Retinal fundus photograph: 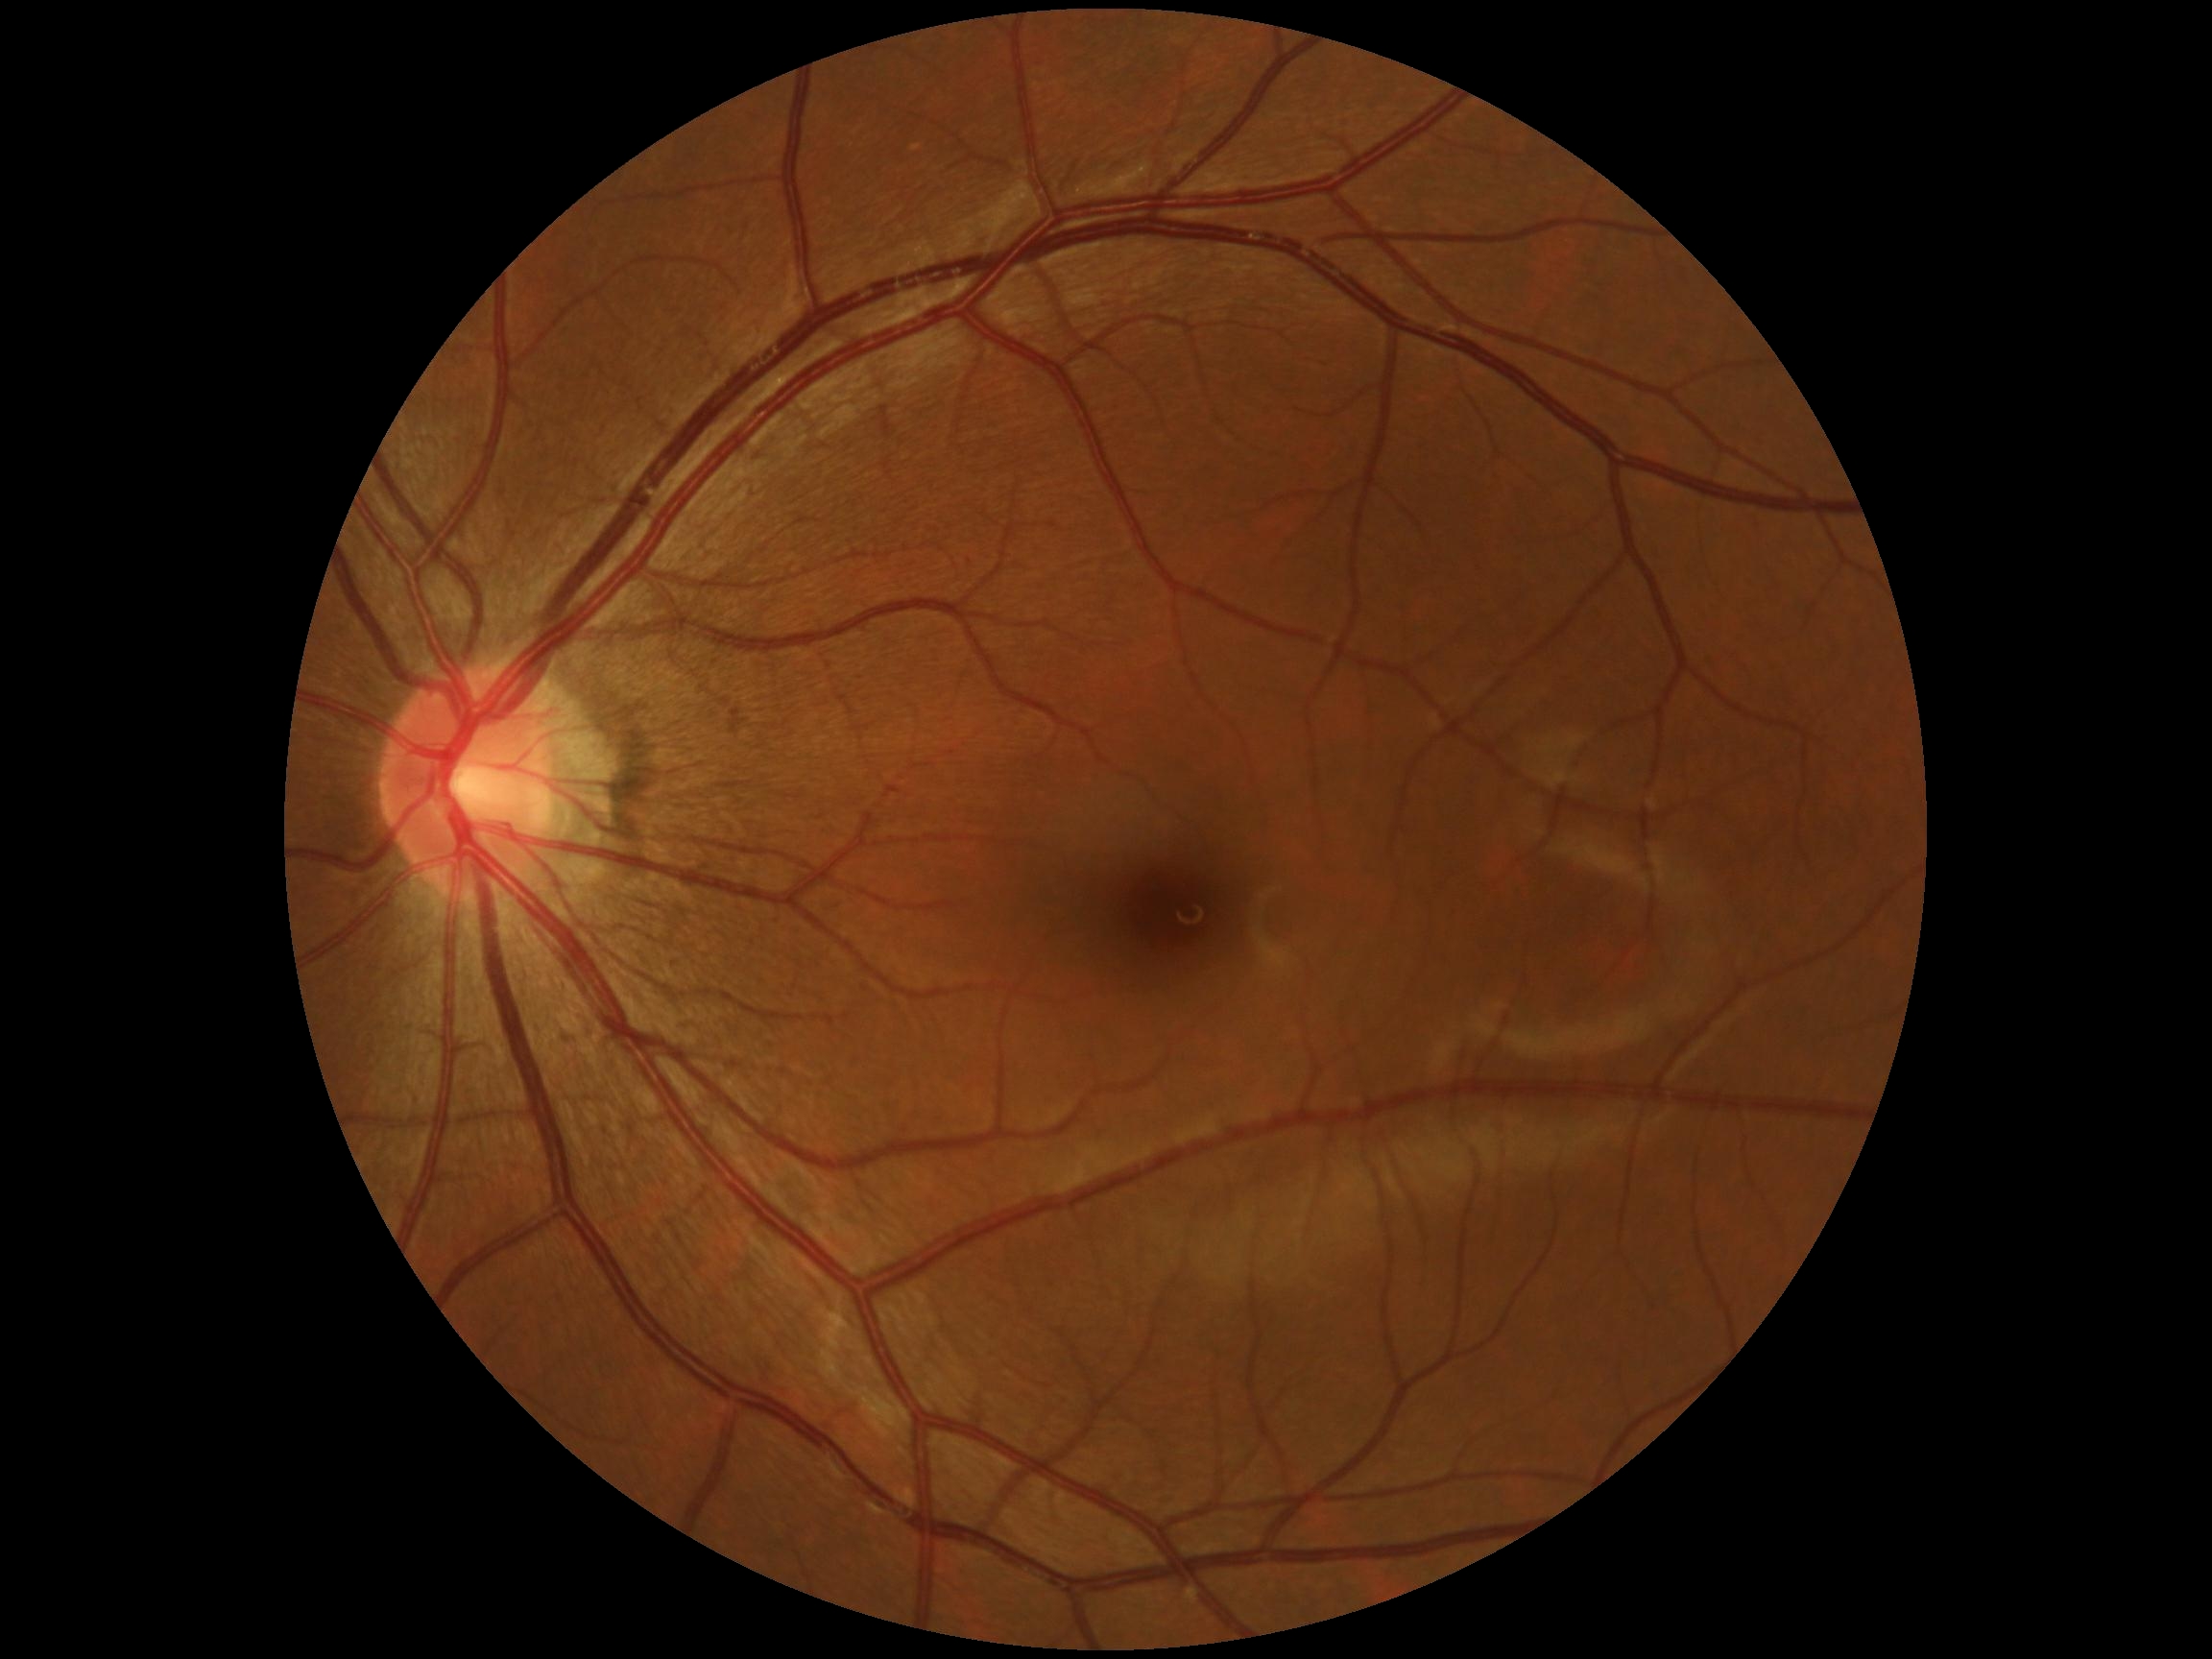
- DR impression — negative for DR
- diabetic retinopathy — 0/4